Pupil-dilated.
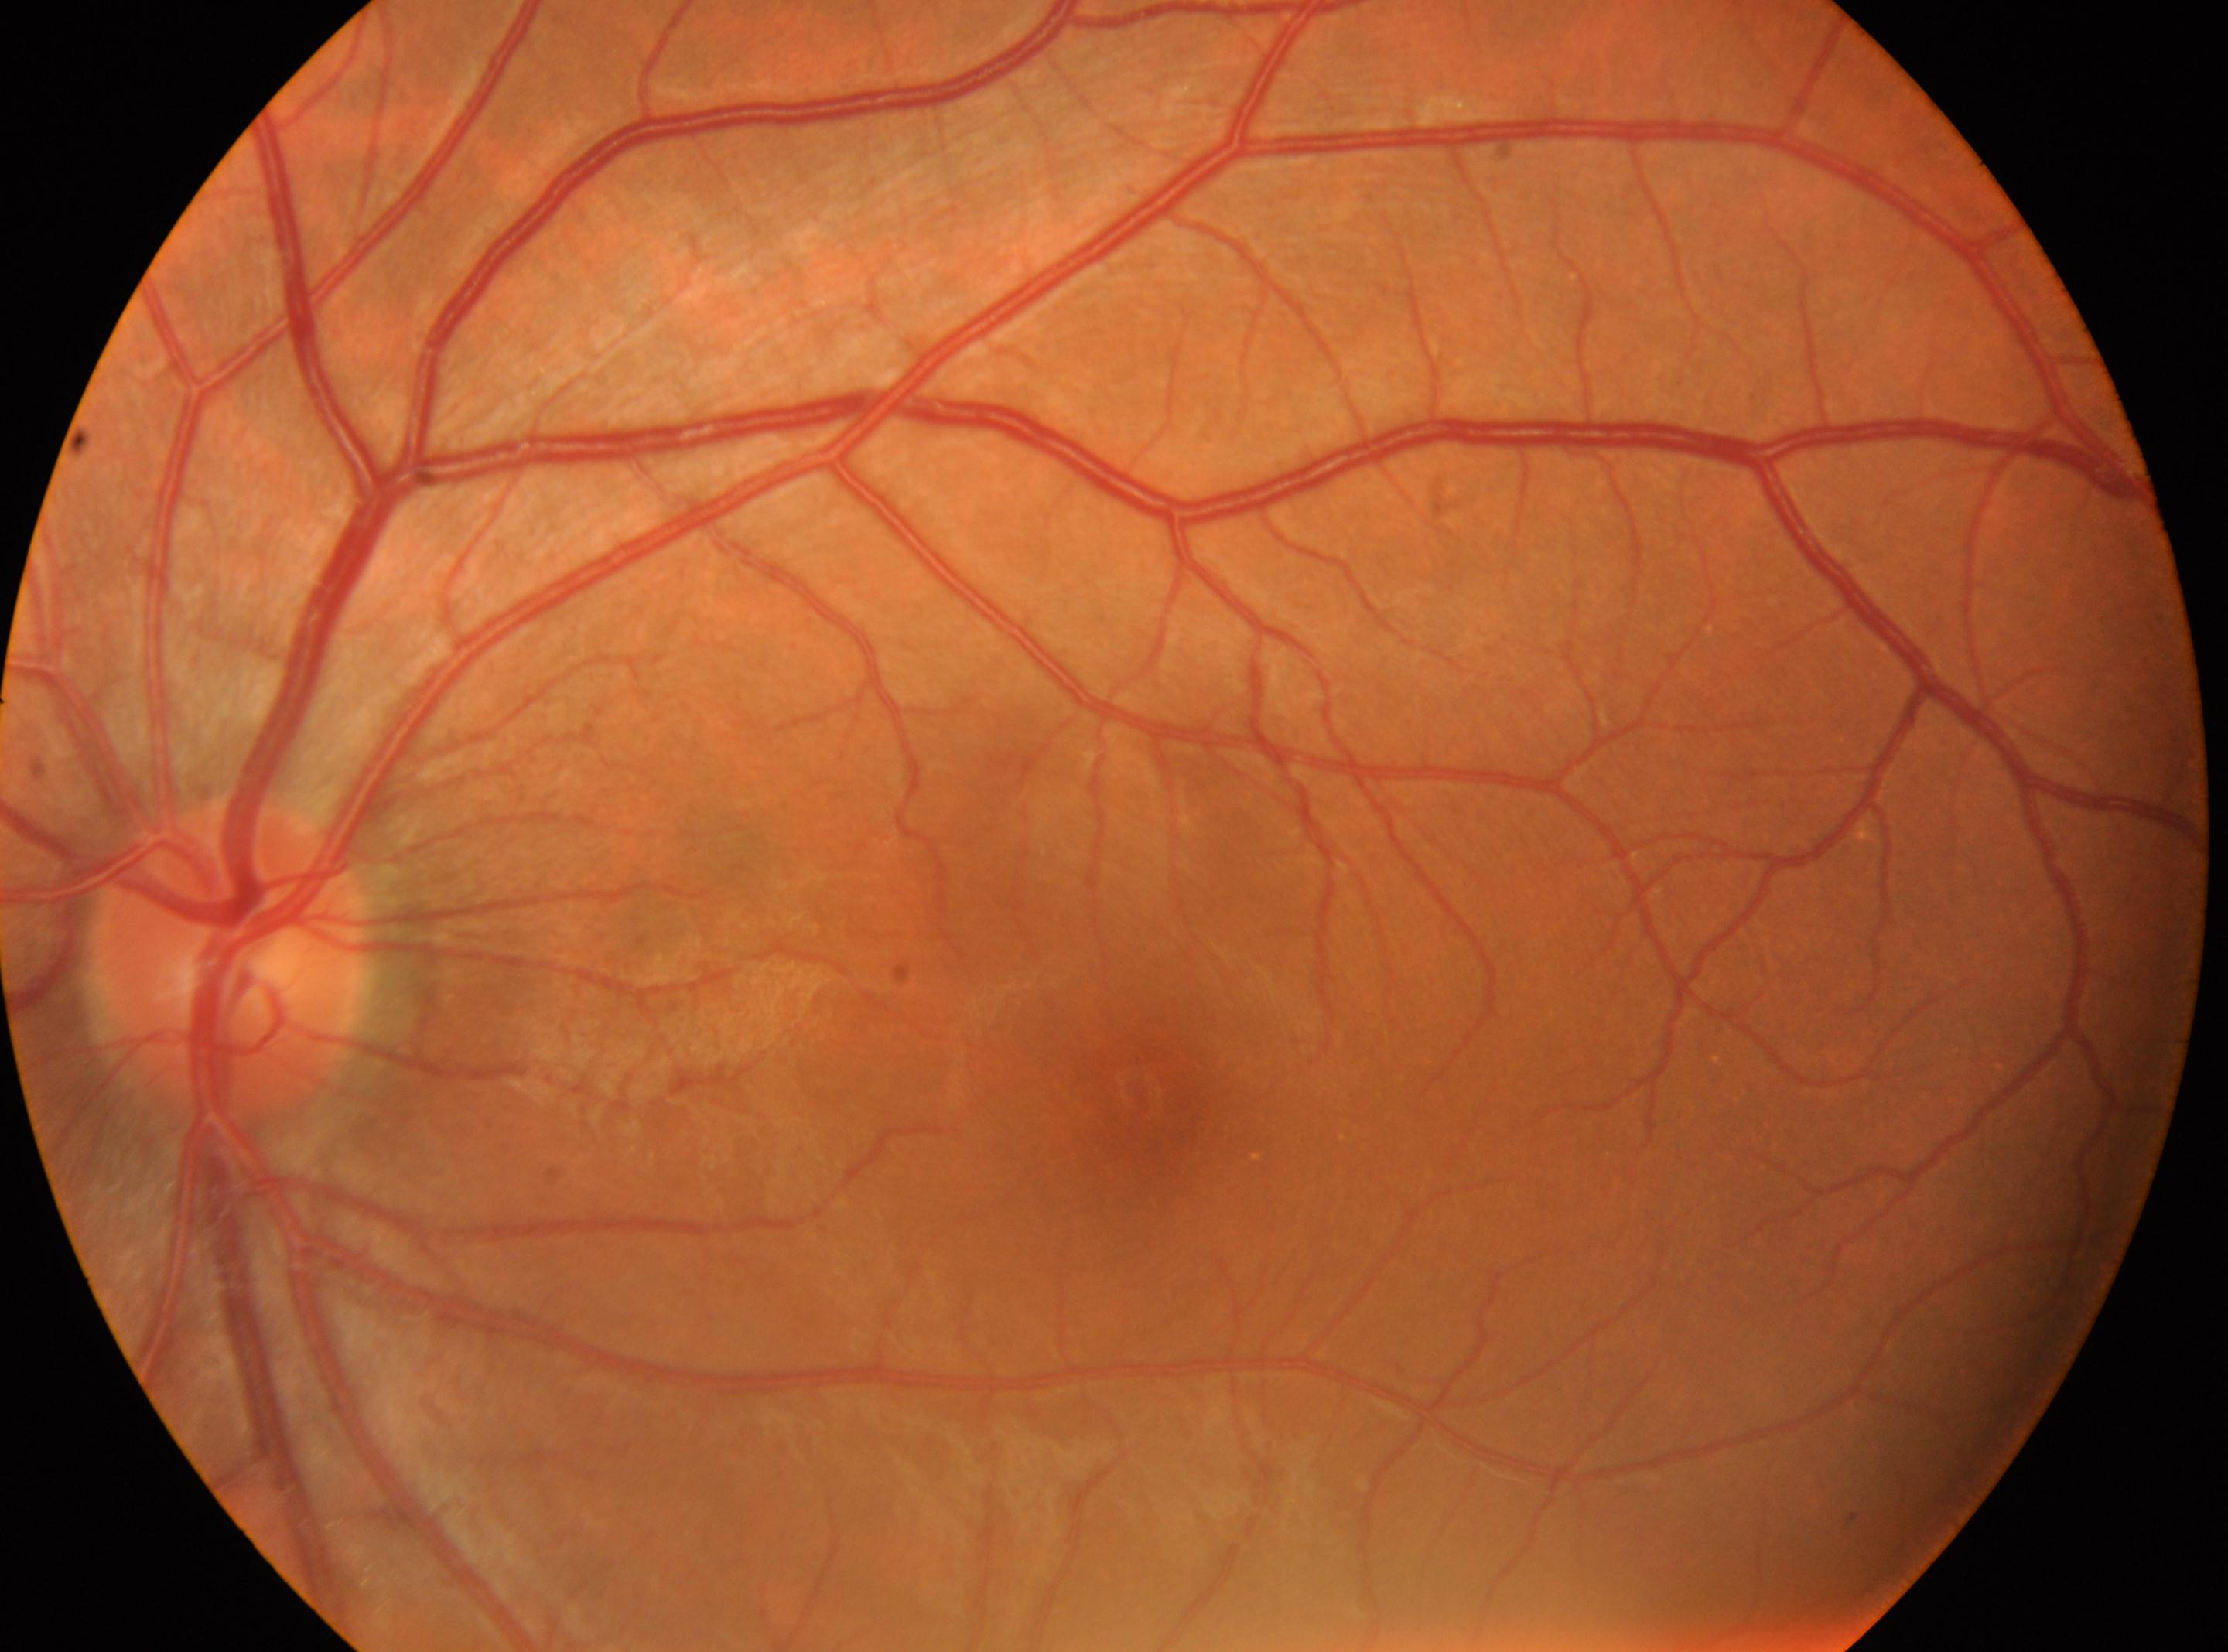
ONH: [227, 960]
laterality: left eye
fovea centralis: [1137, 1091]
DR stage: 0